Image size 2352x1568 — 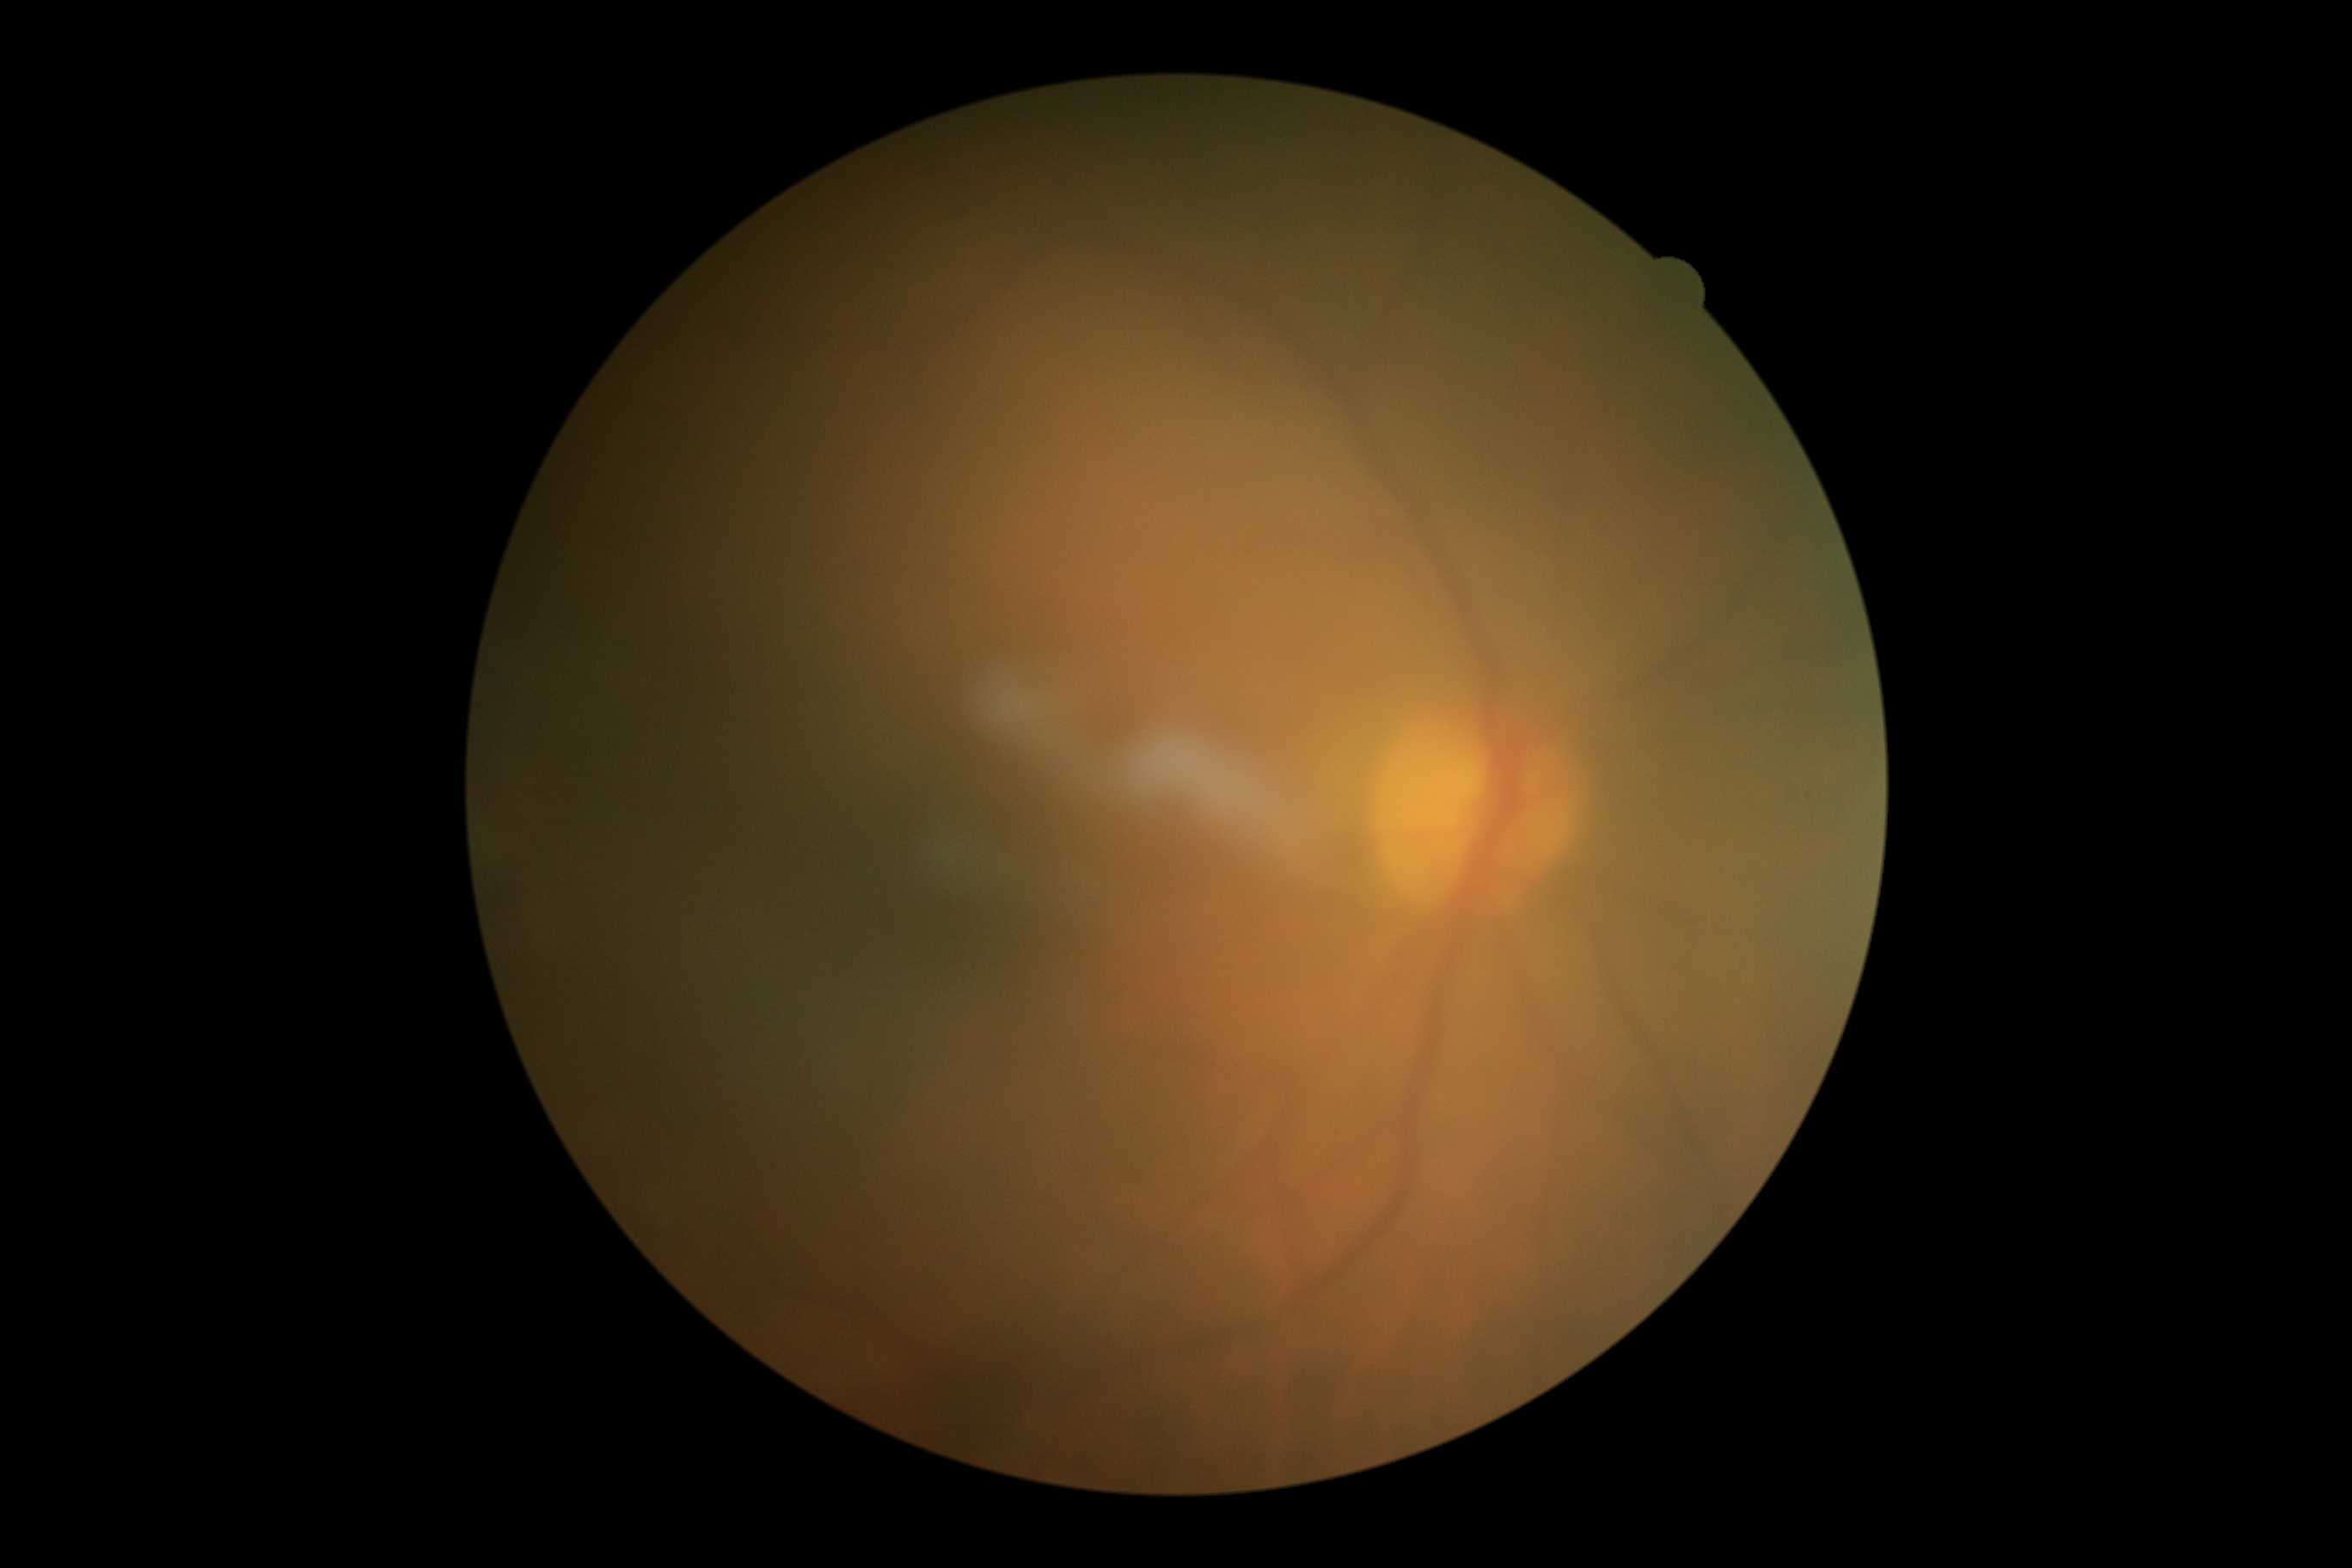 {"dr_impression": "no DR findings", "dr_grade": "no apparent diabetic retinopathy (grade 0)"}